FOV: 45 degrees:
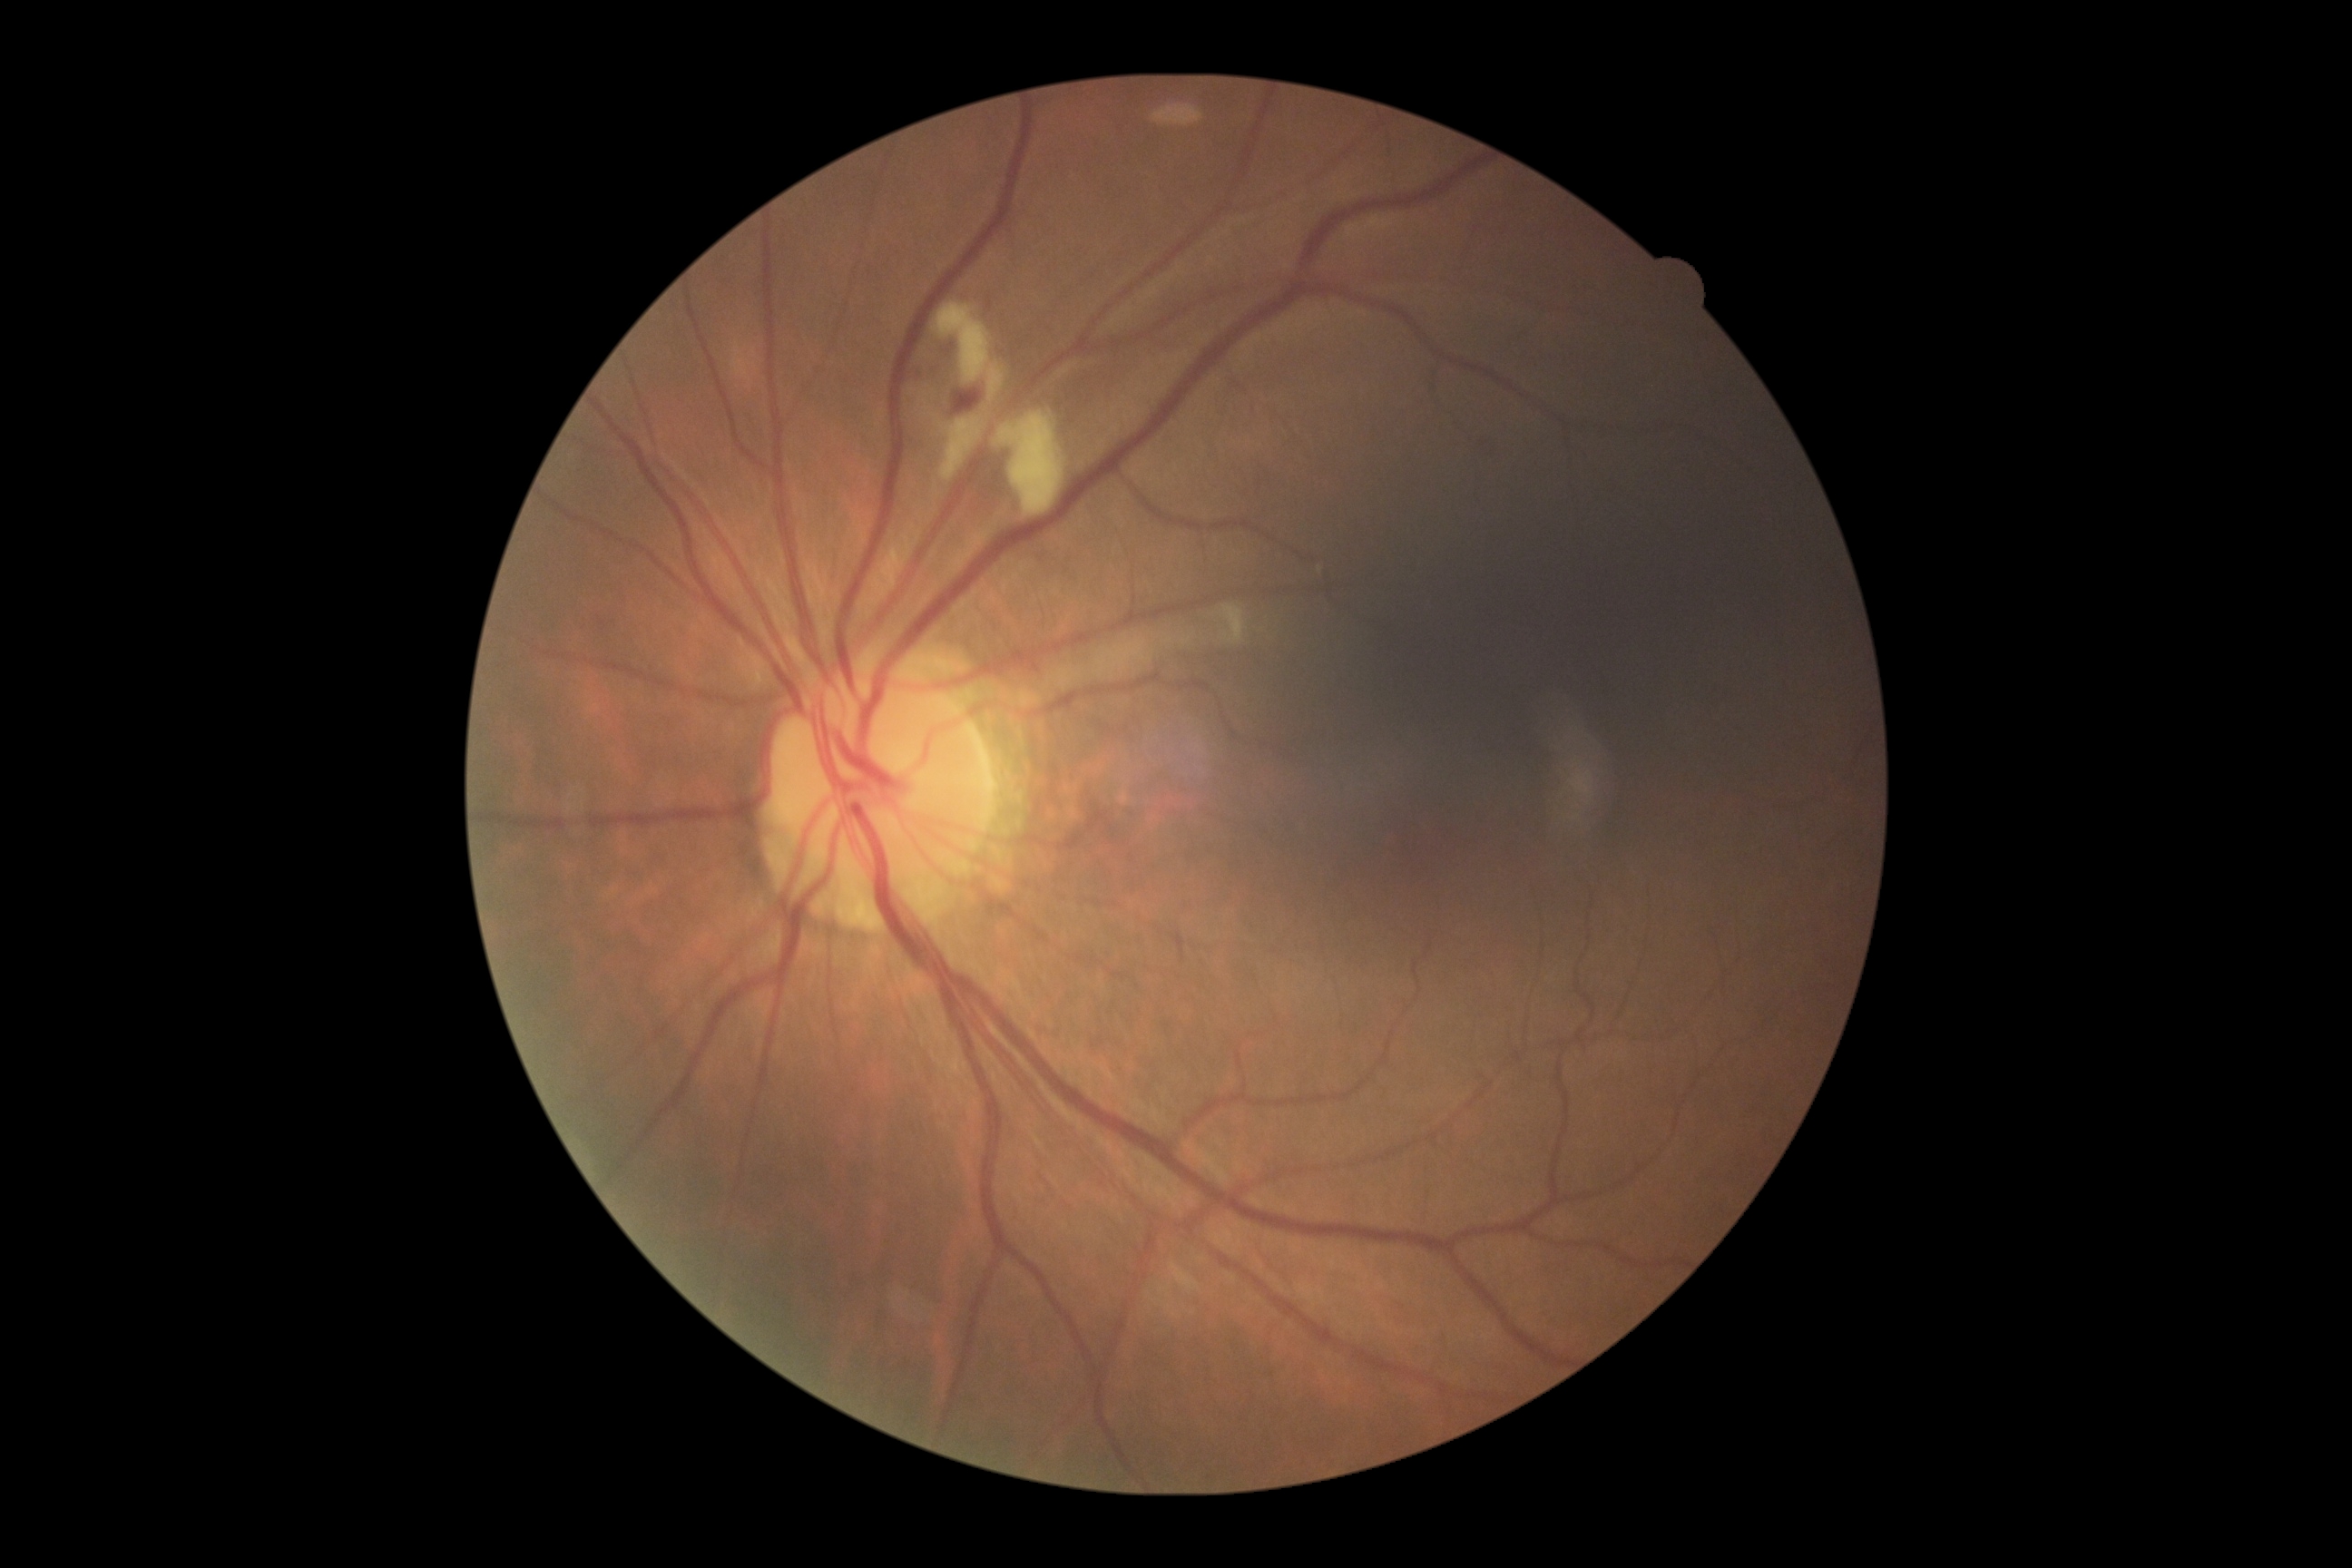

DR stage is moderate NPDR (grade 2). DR class: non-proliferative diabetic retinopathy.